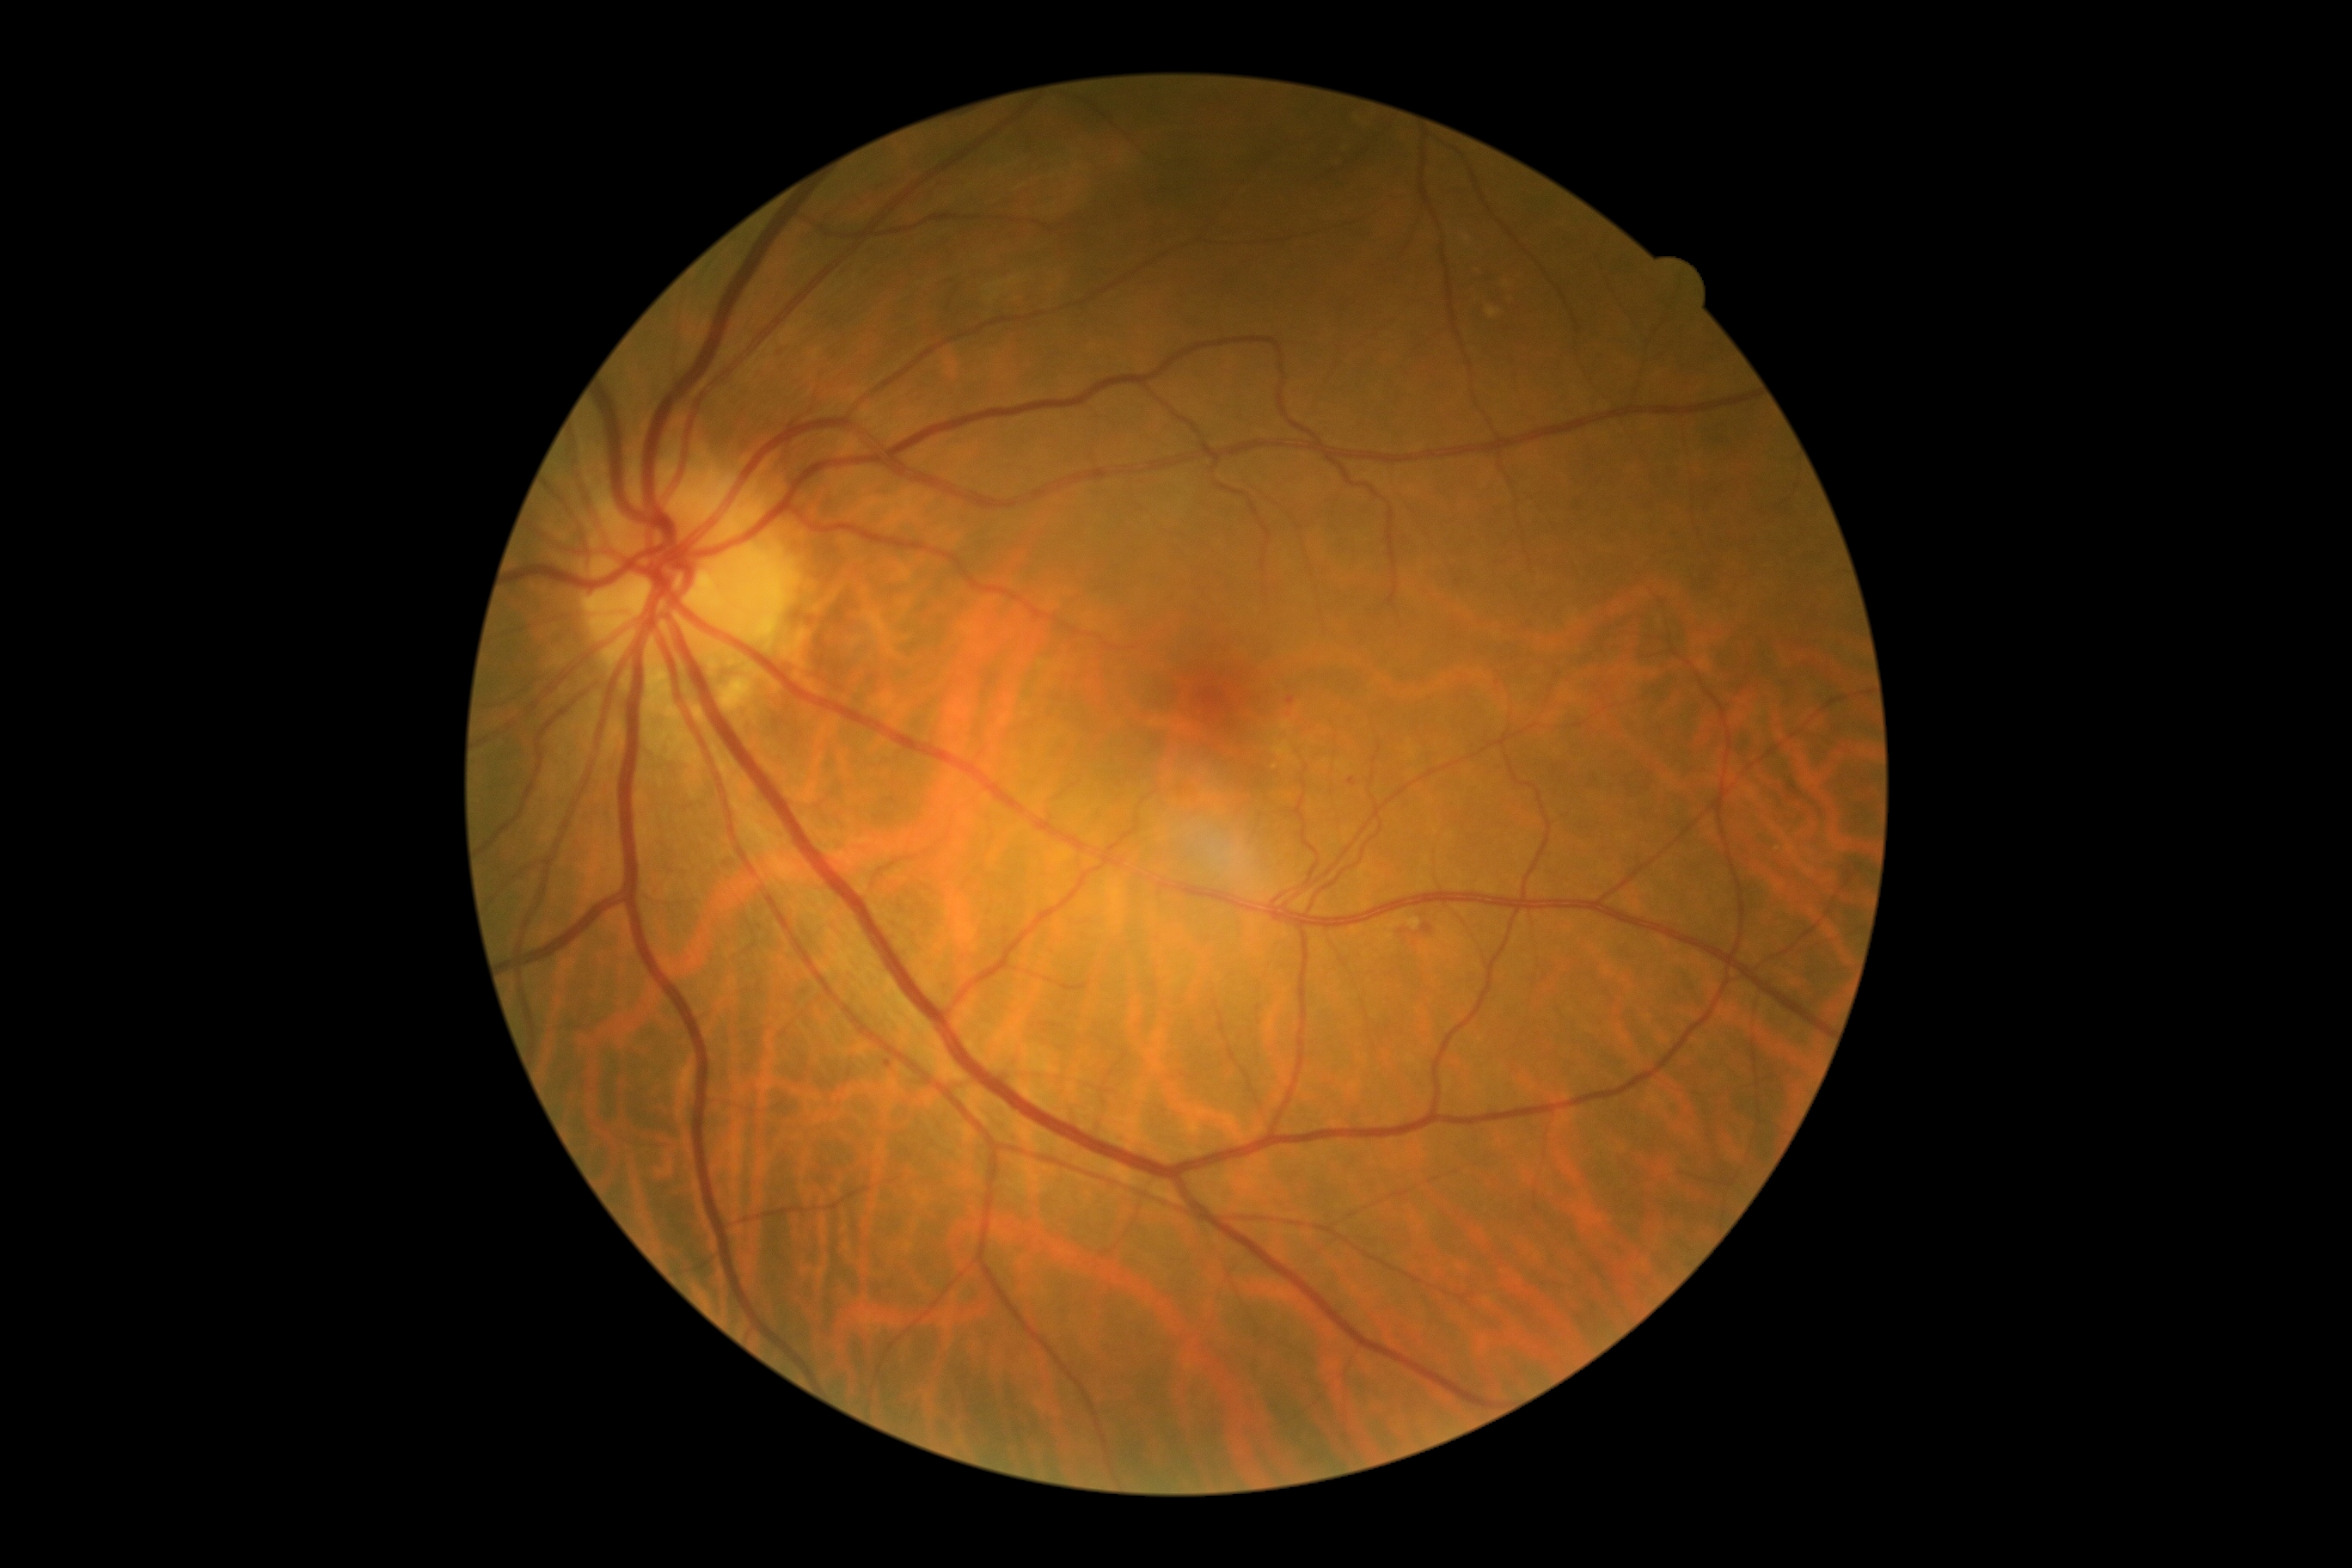 diabetic retinopathy grade: moderate non-proliferative diabetic retinopathy (2)
DR class: non-proliferative diabetic retinopathy